640 by 480 pixels; camera: Clarity RetCam 3 (130° FOV); infant wide-field retinal image:
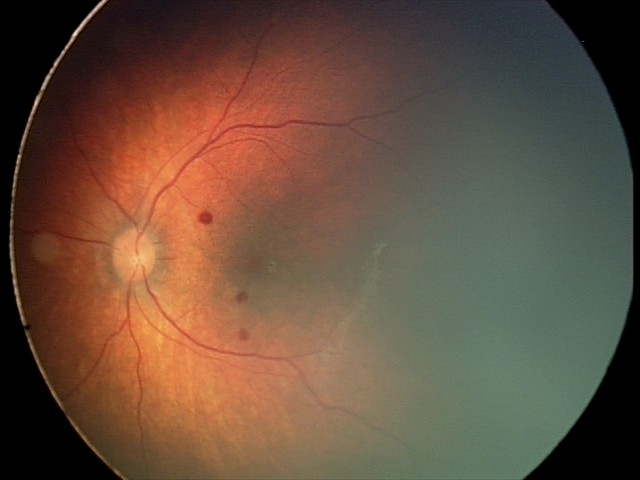

Q: What is the screening diagnosis?
A: retinal hemorrhages